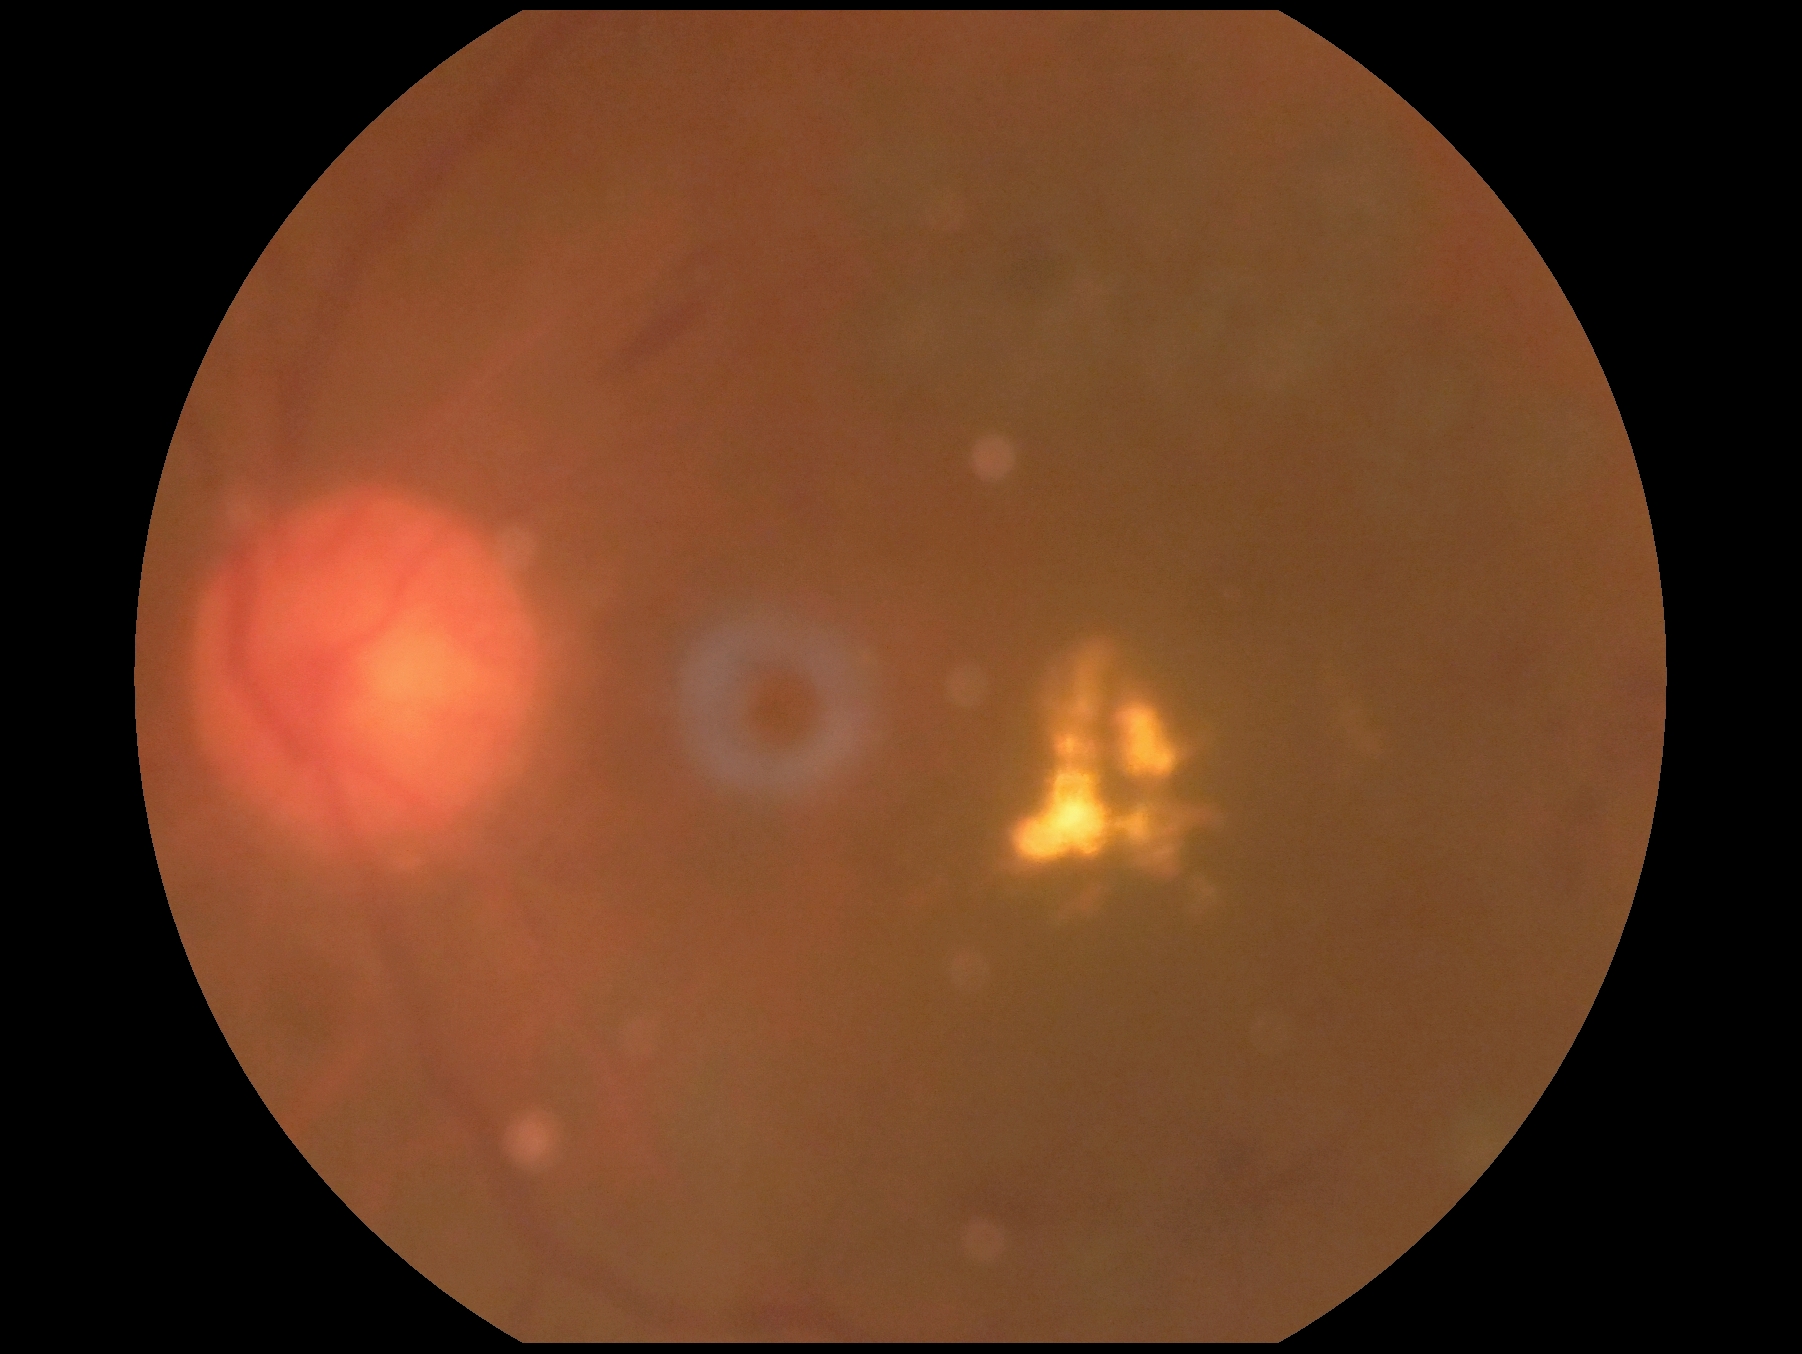
  dr_grade: grade 2 (moderate NPDR) — more than just microaneurysms but less than severe NPDR